CFP:
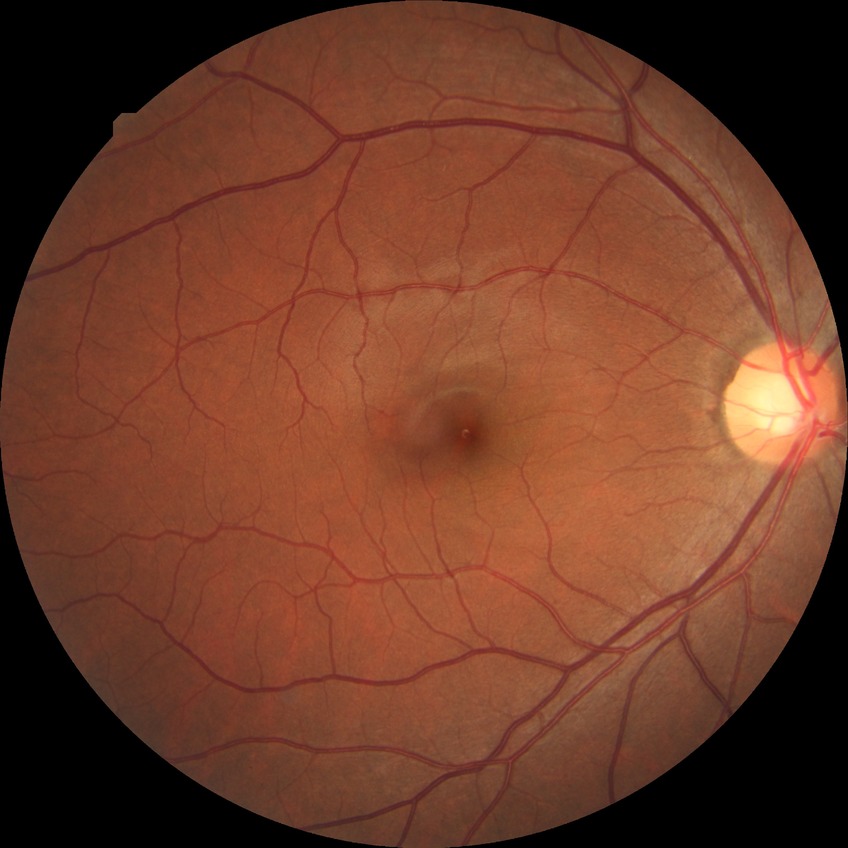 modified Davis grading = no diabetic retinopathy